Pediatric retinal photograph (wide-field): 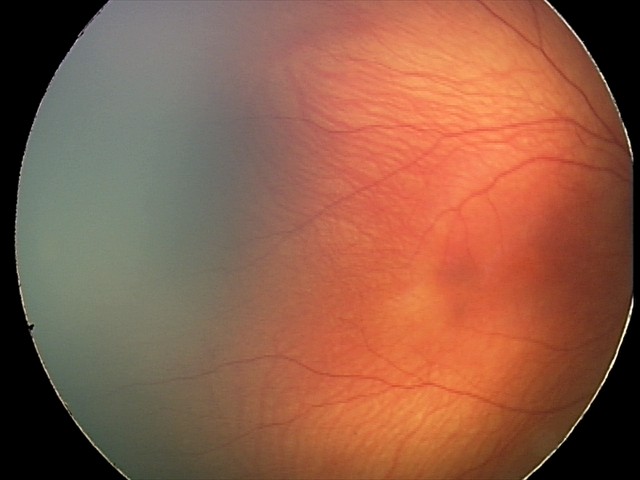
Screening examination with no abnormal retinal findings.